Captured with the Phoenix ICON (100° field of view); 1240x1240px; wide-field contact fundus photograph of an infant — 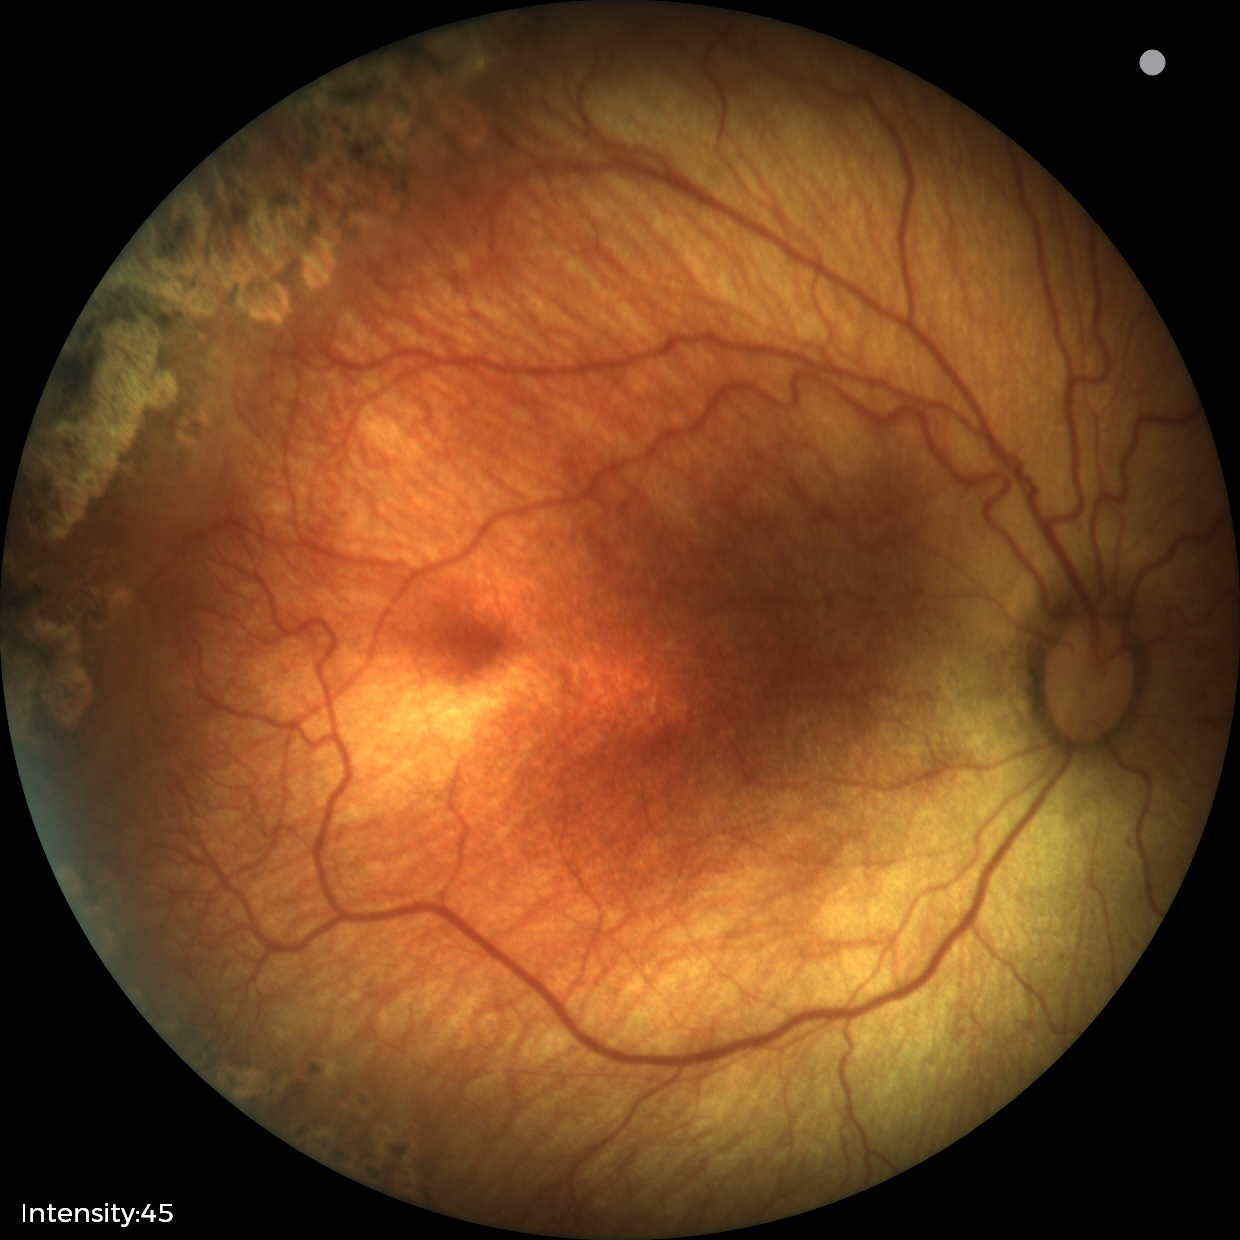 From an examination with diagnosis of status post ROP.